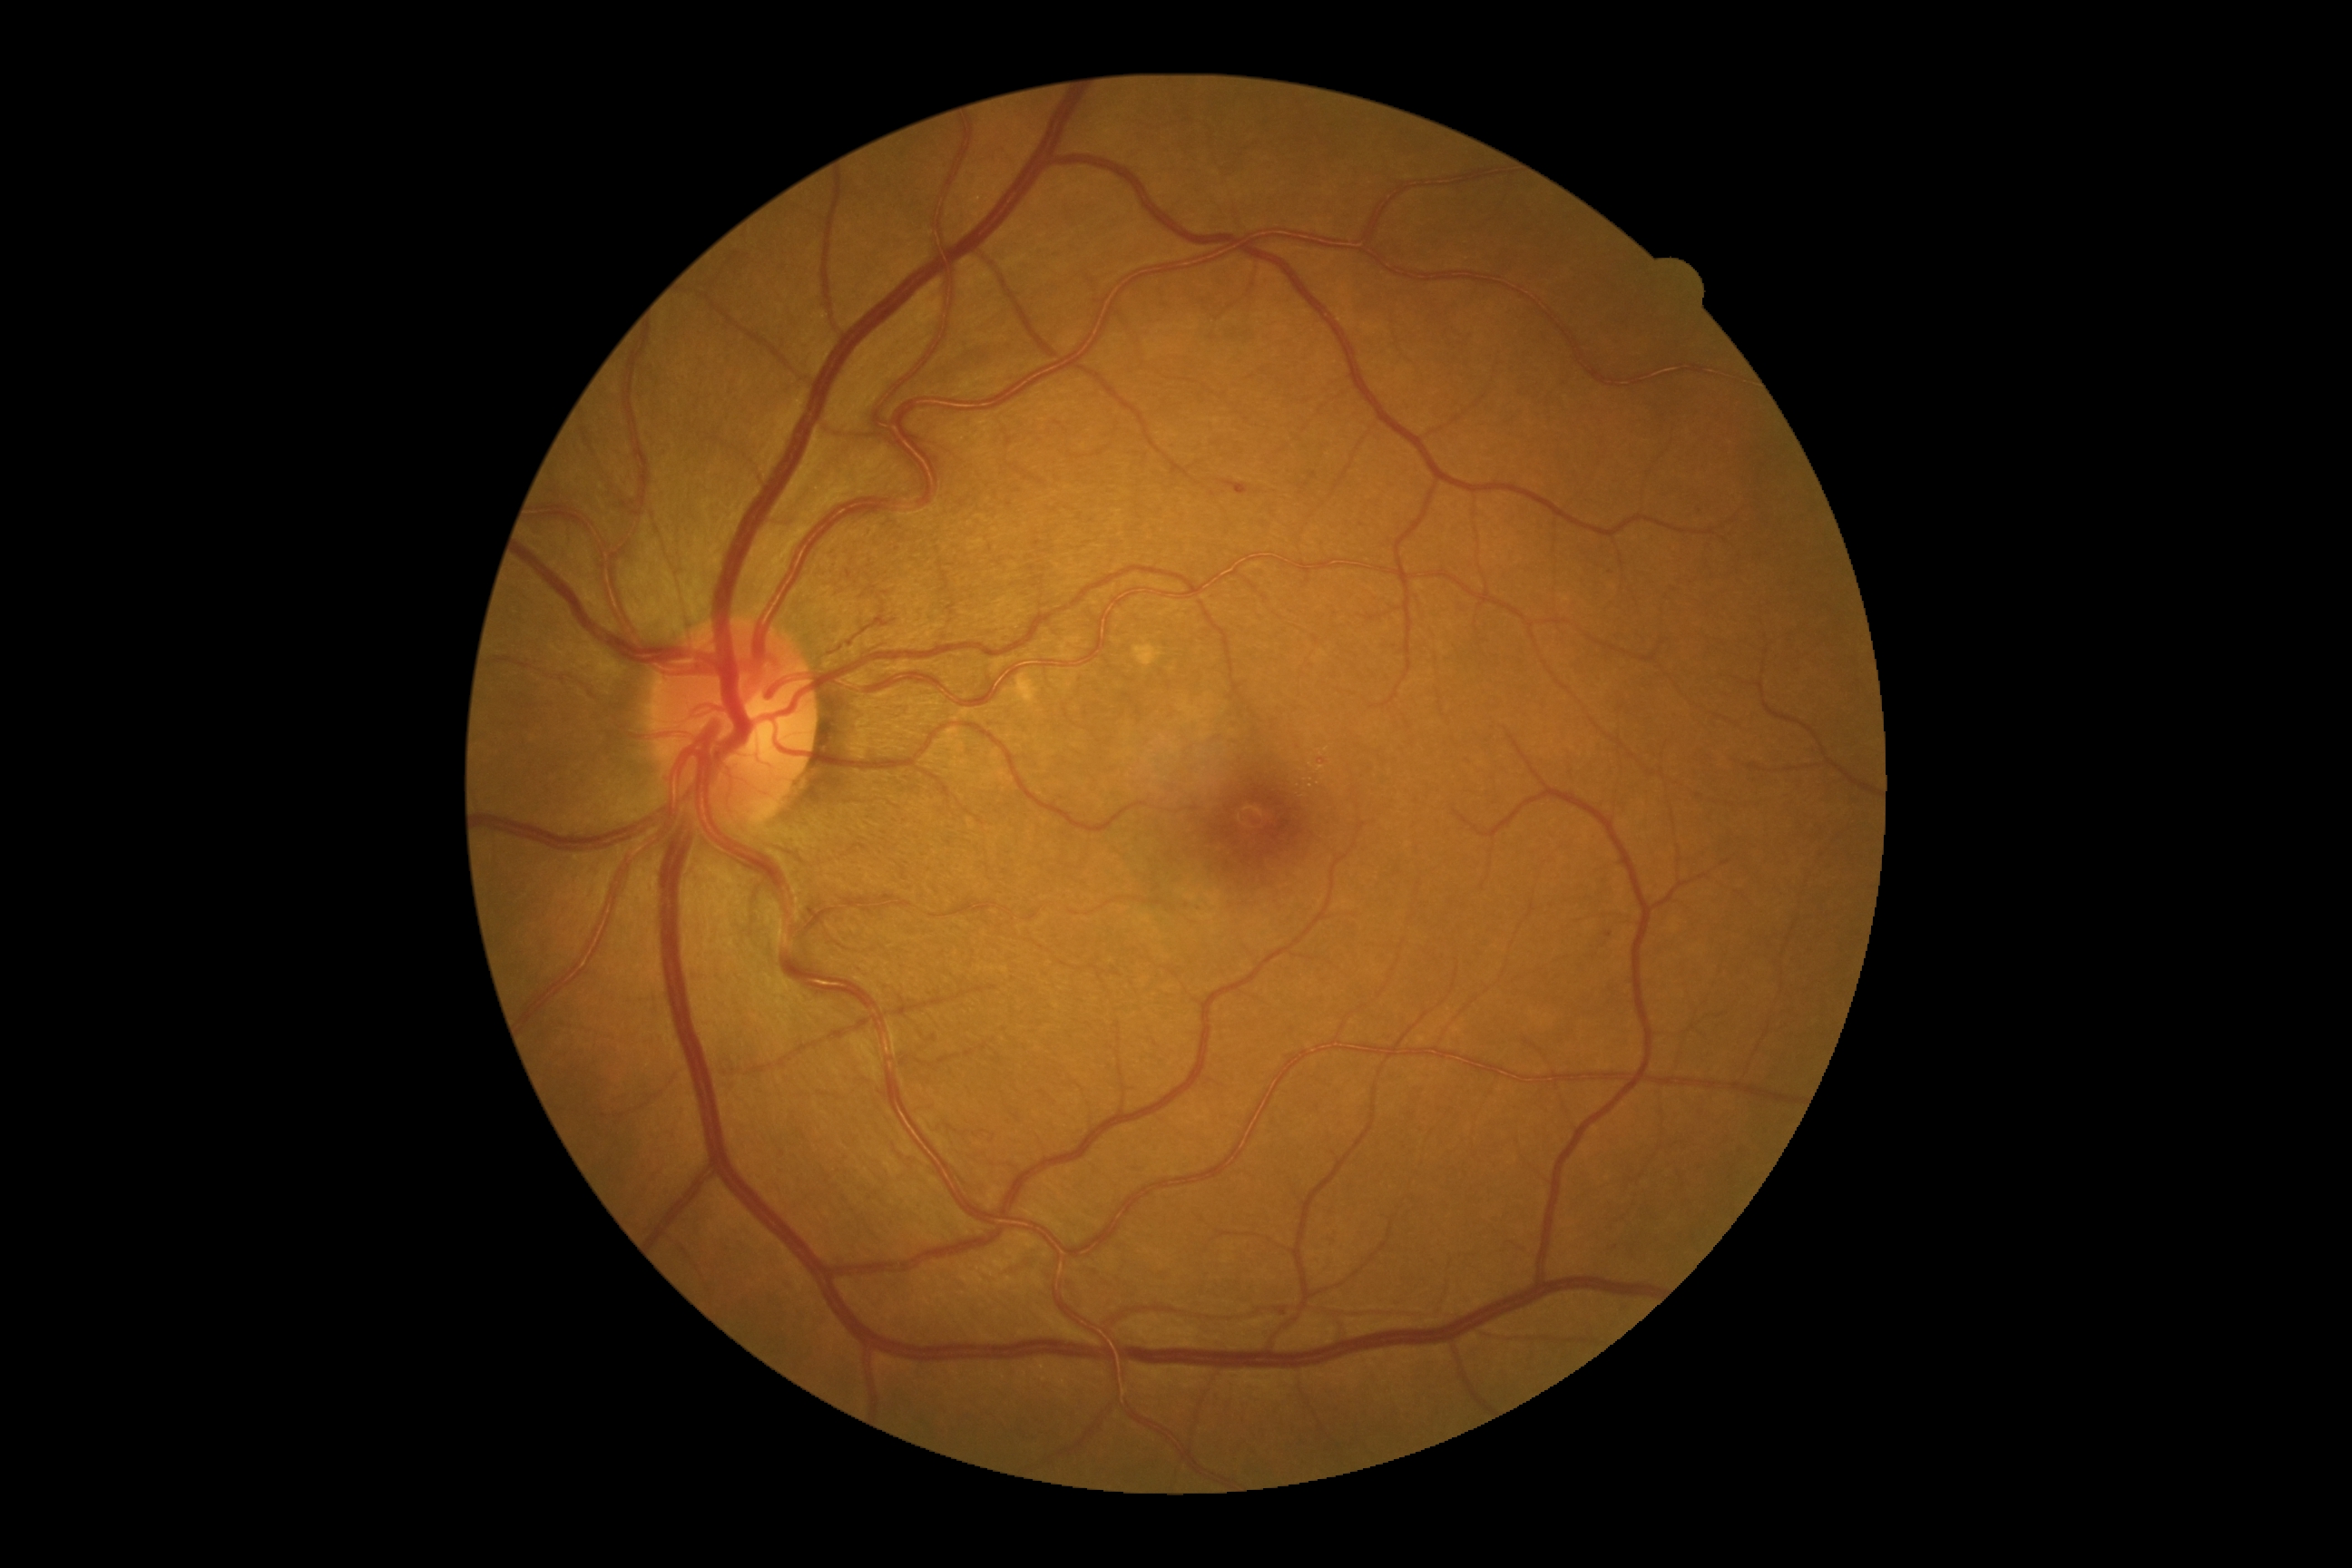

DR stage is moderate non-proliferative diabetic retinopathy (grade 2) — more than just microaneurysms but less than severe NPDR.